Posterior pole photograph, acquired with a NIDEK AFC-230:
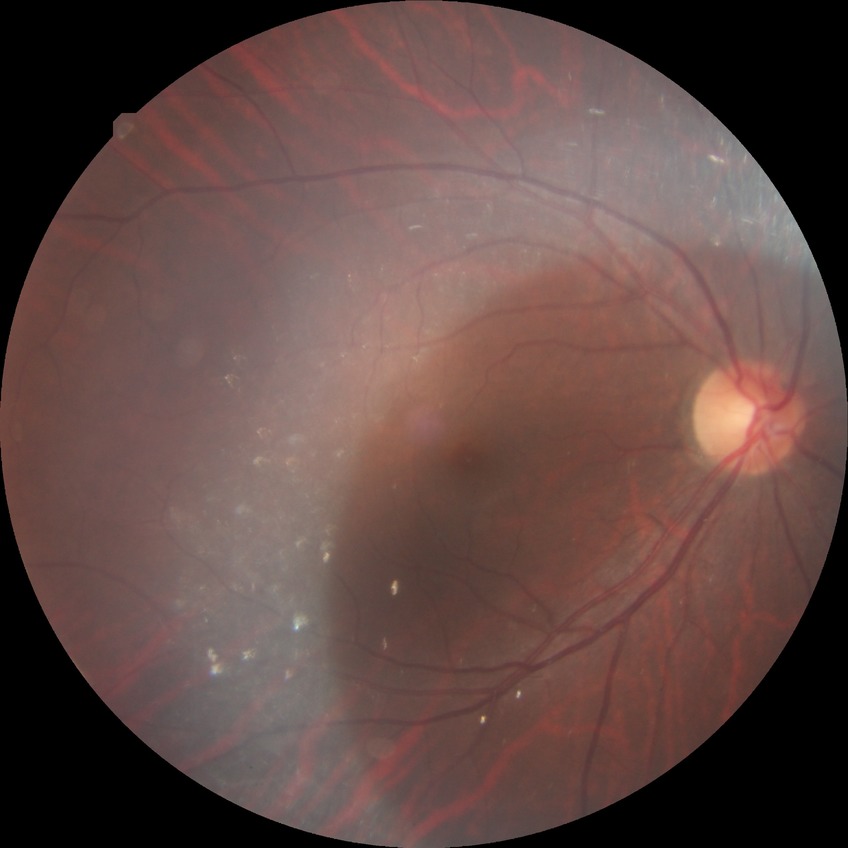

Davis DR grade=NDR.